2212x1659, fundus photo, 45° FOV.
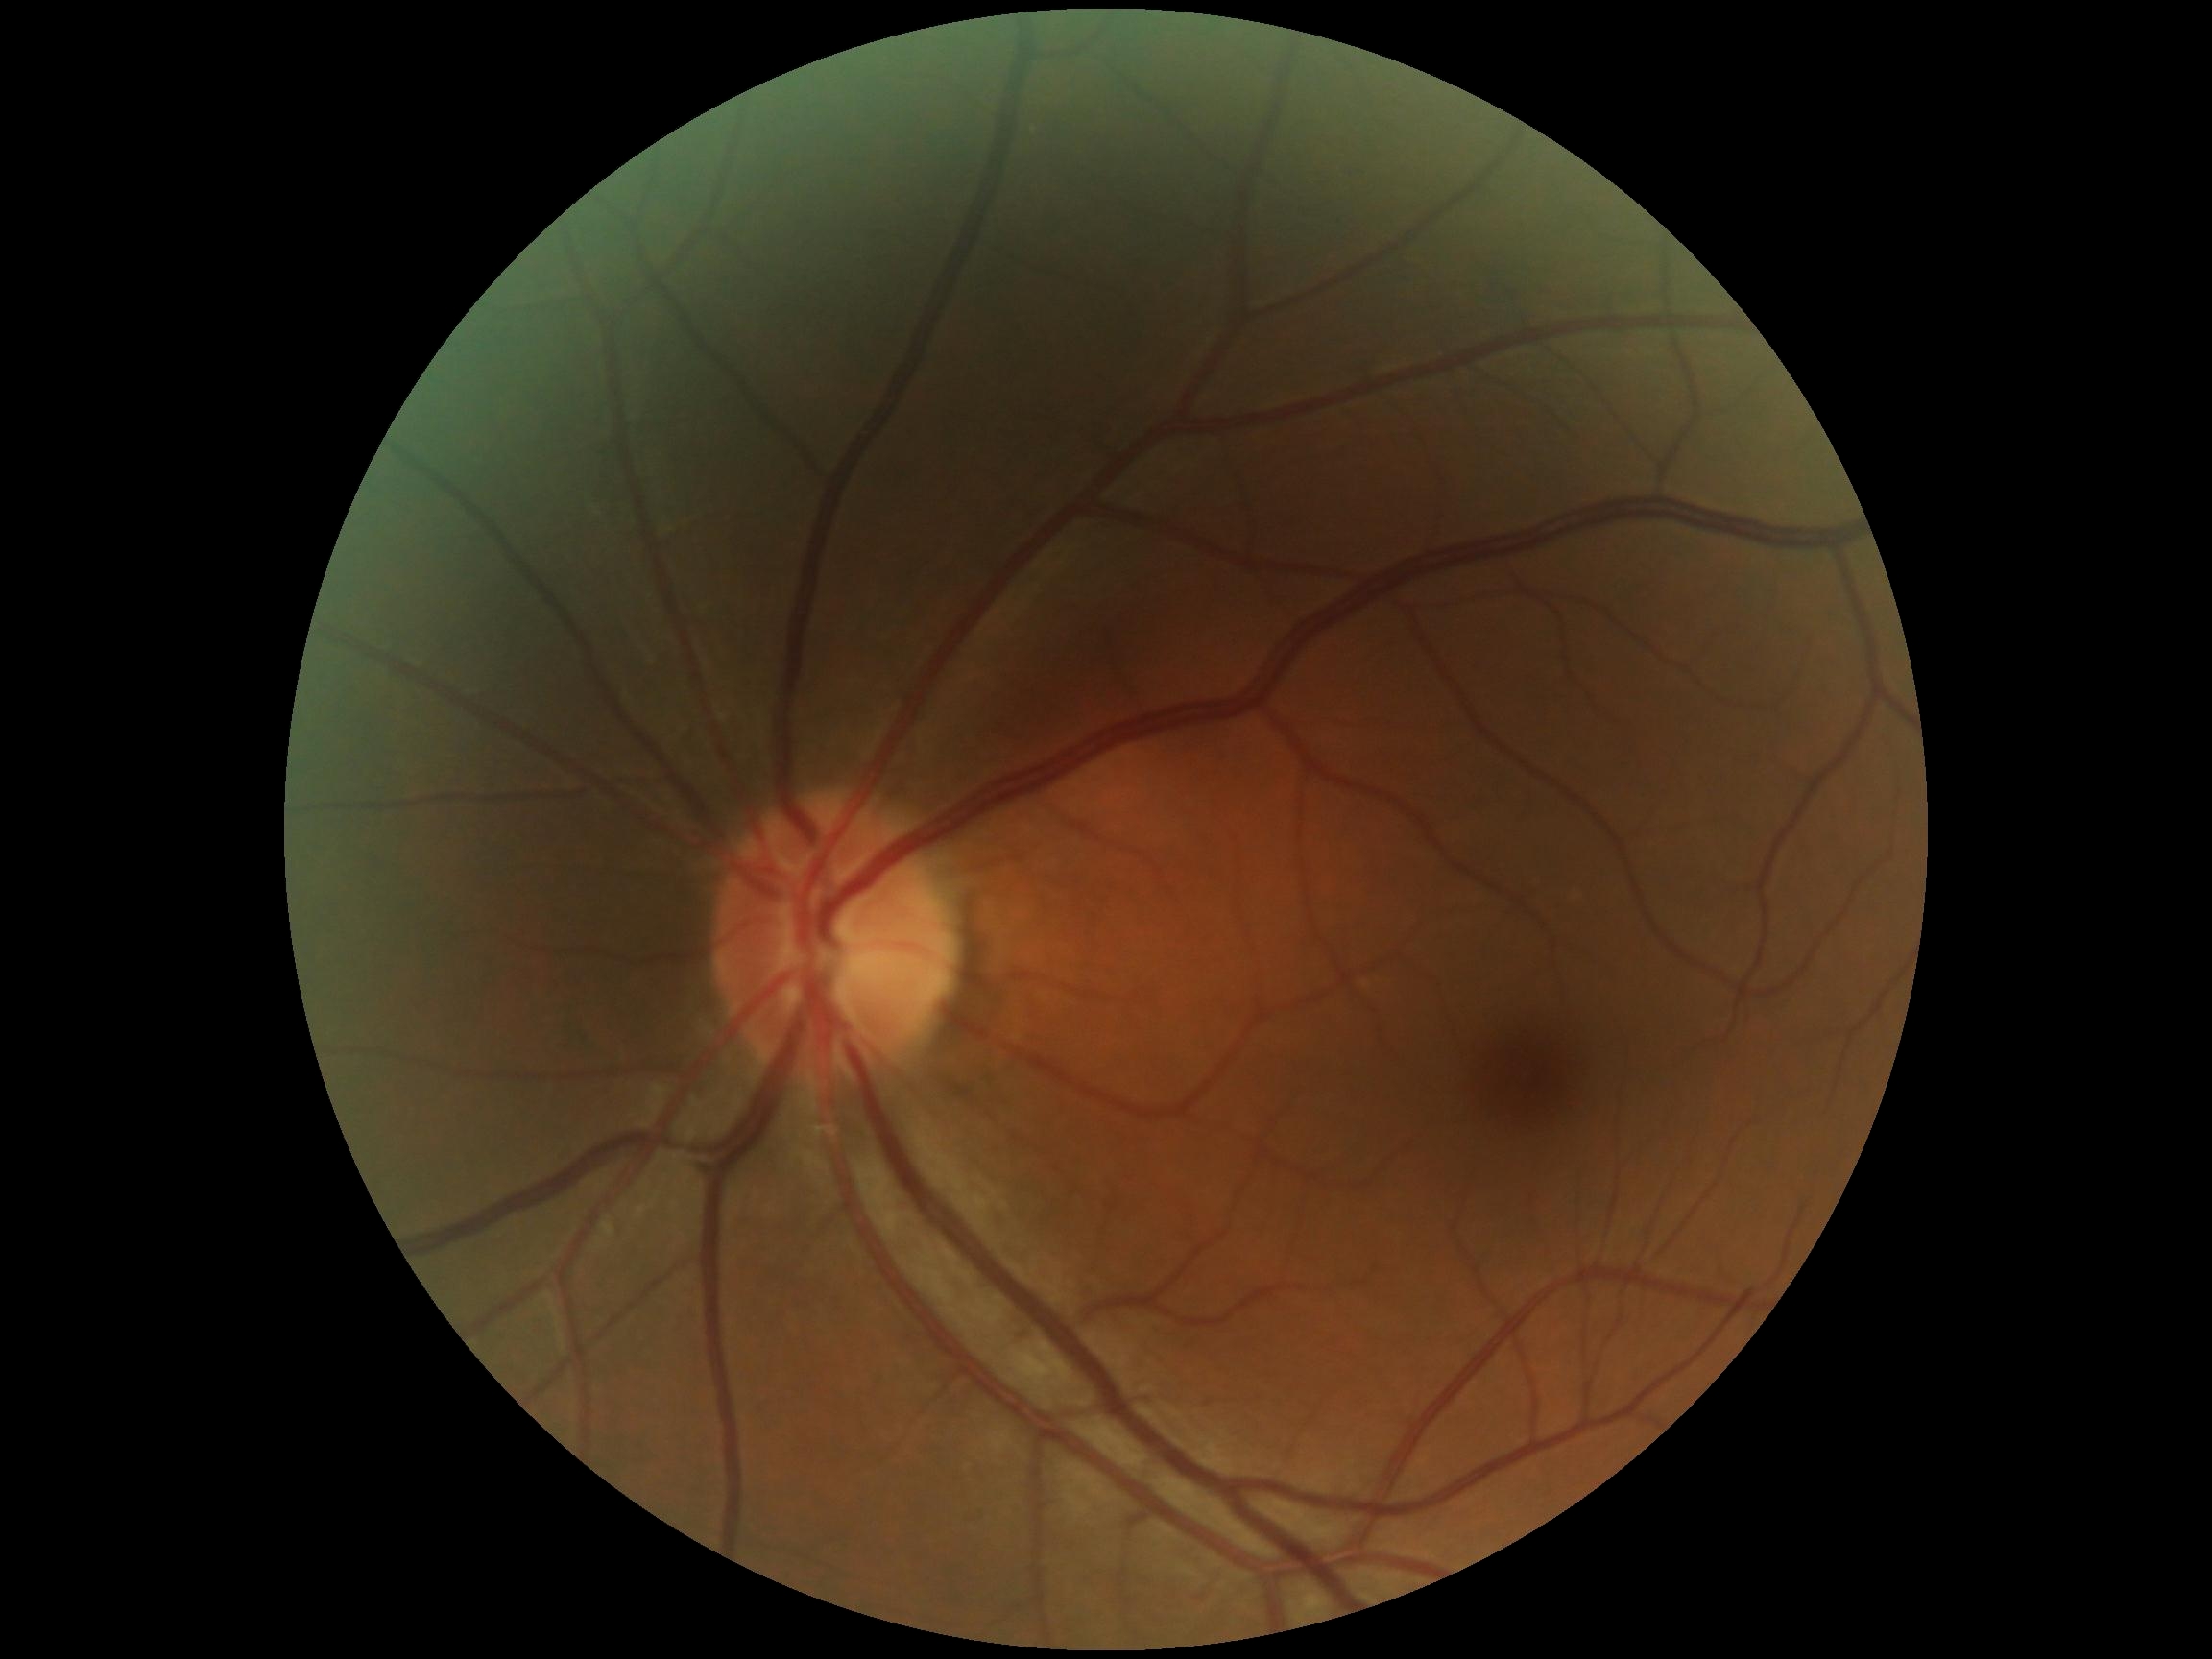
Diabetic retinopathy grade: 0 (no apparent retinopathy).